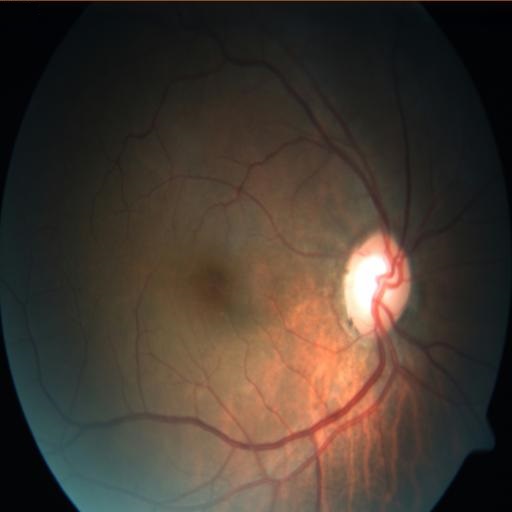

Fundus appearance consistent with optic disc pallor.